Wide-field contact fundus photograph of an infant; captured with the Phoenix ICON (100° field of view): 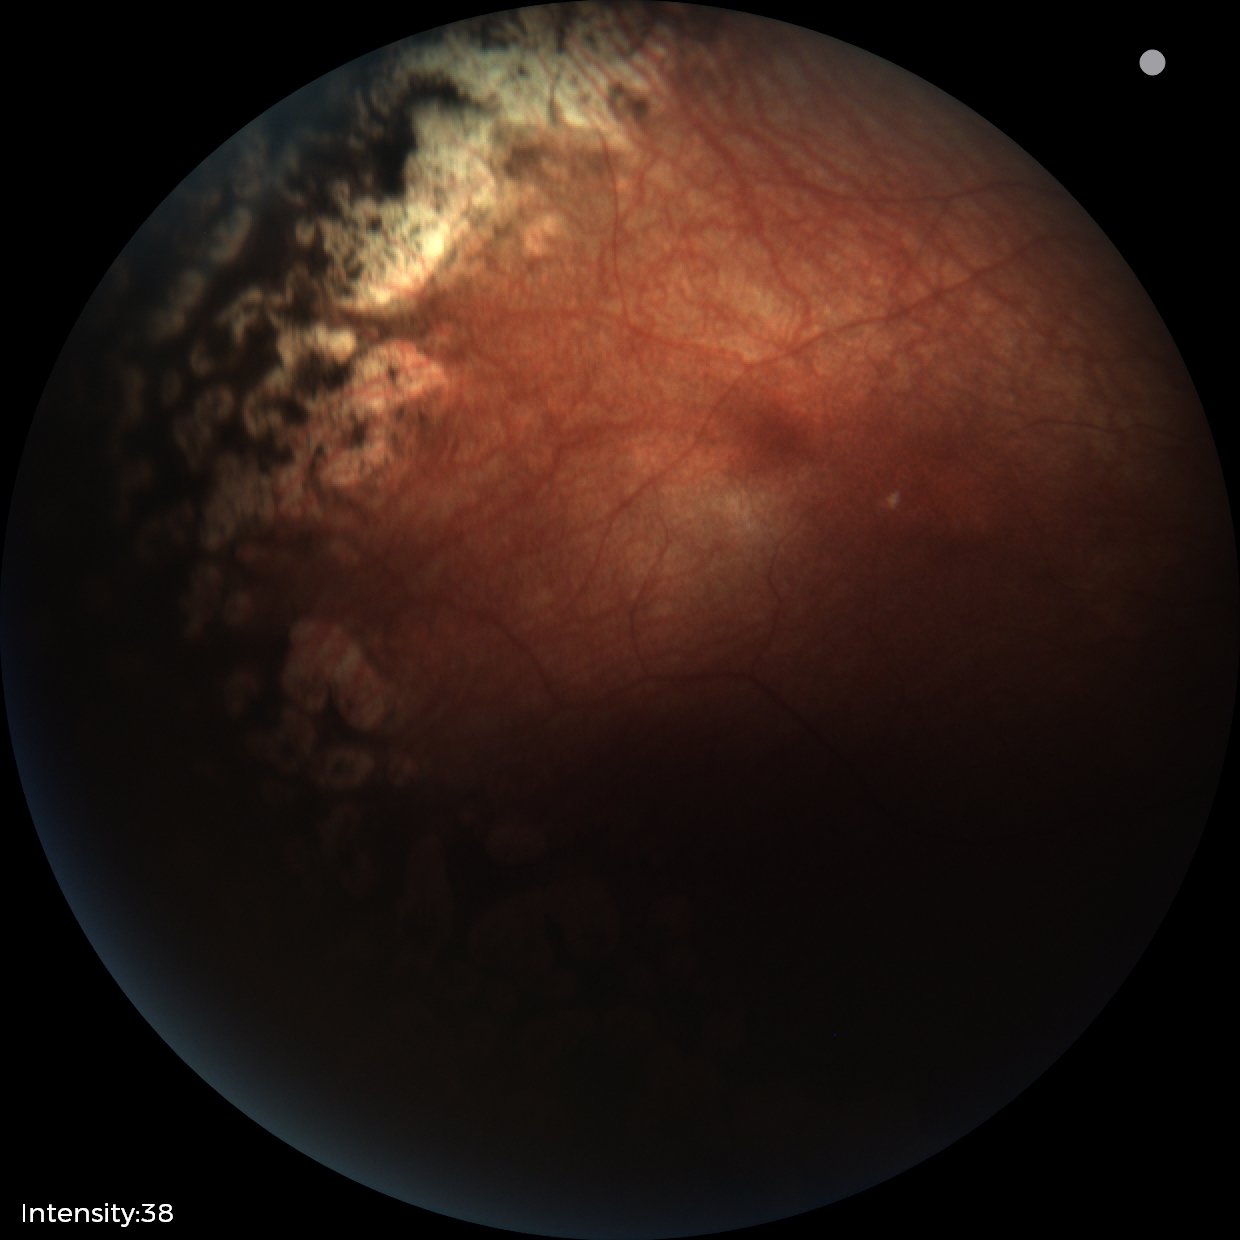

Series diagnosed as status post ROP.